Image size 1240x1240. 100° field of view (Phoenix ICON). Wide-field contact fundus photograph of an infant: 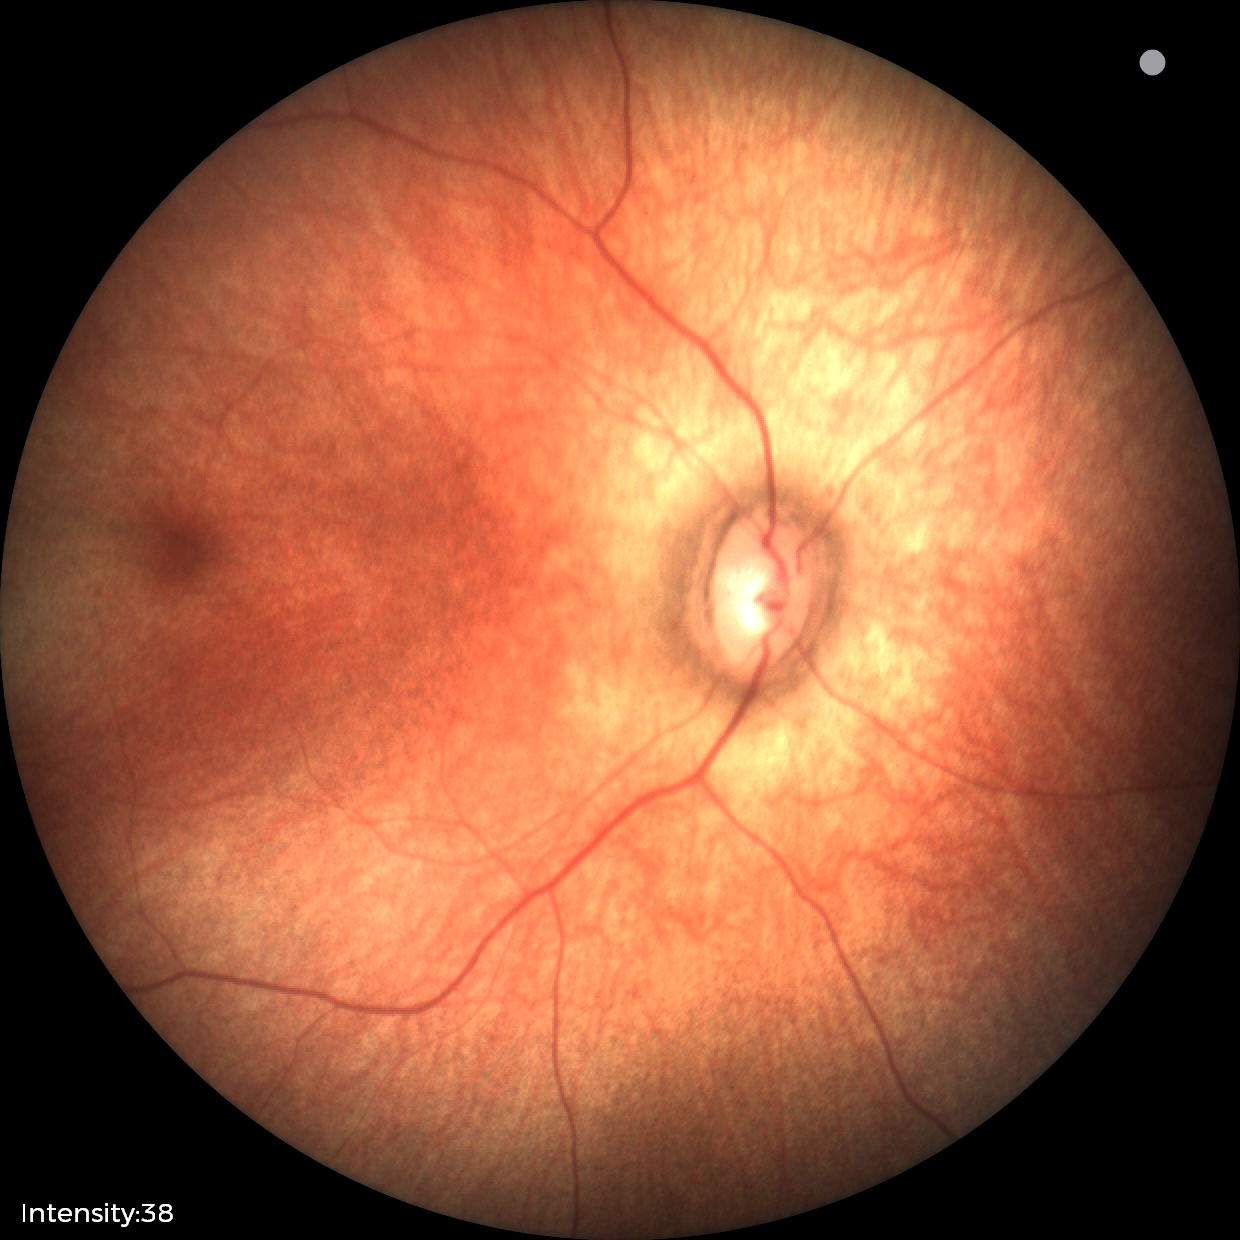 Examination with physiological retinal findings.